45° FOV.
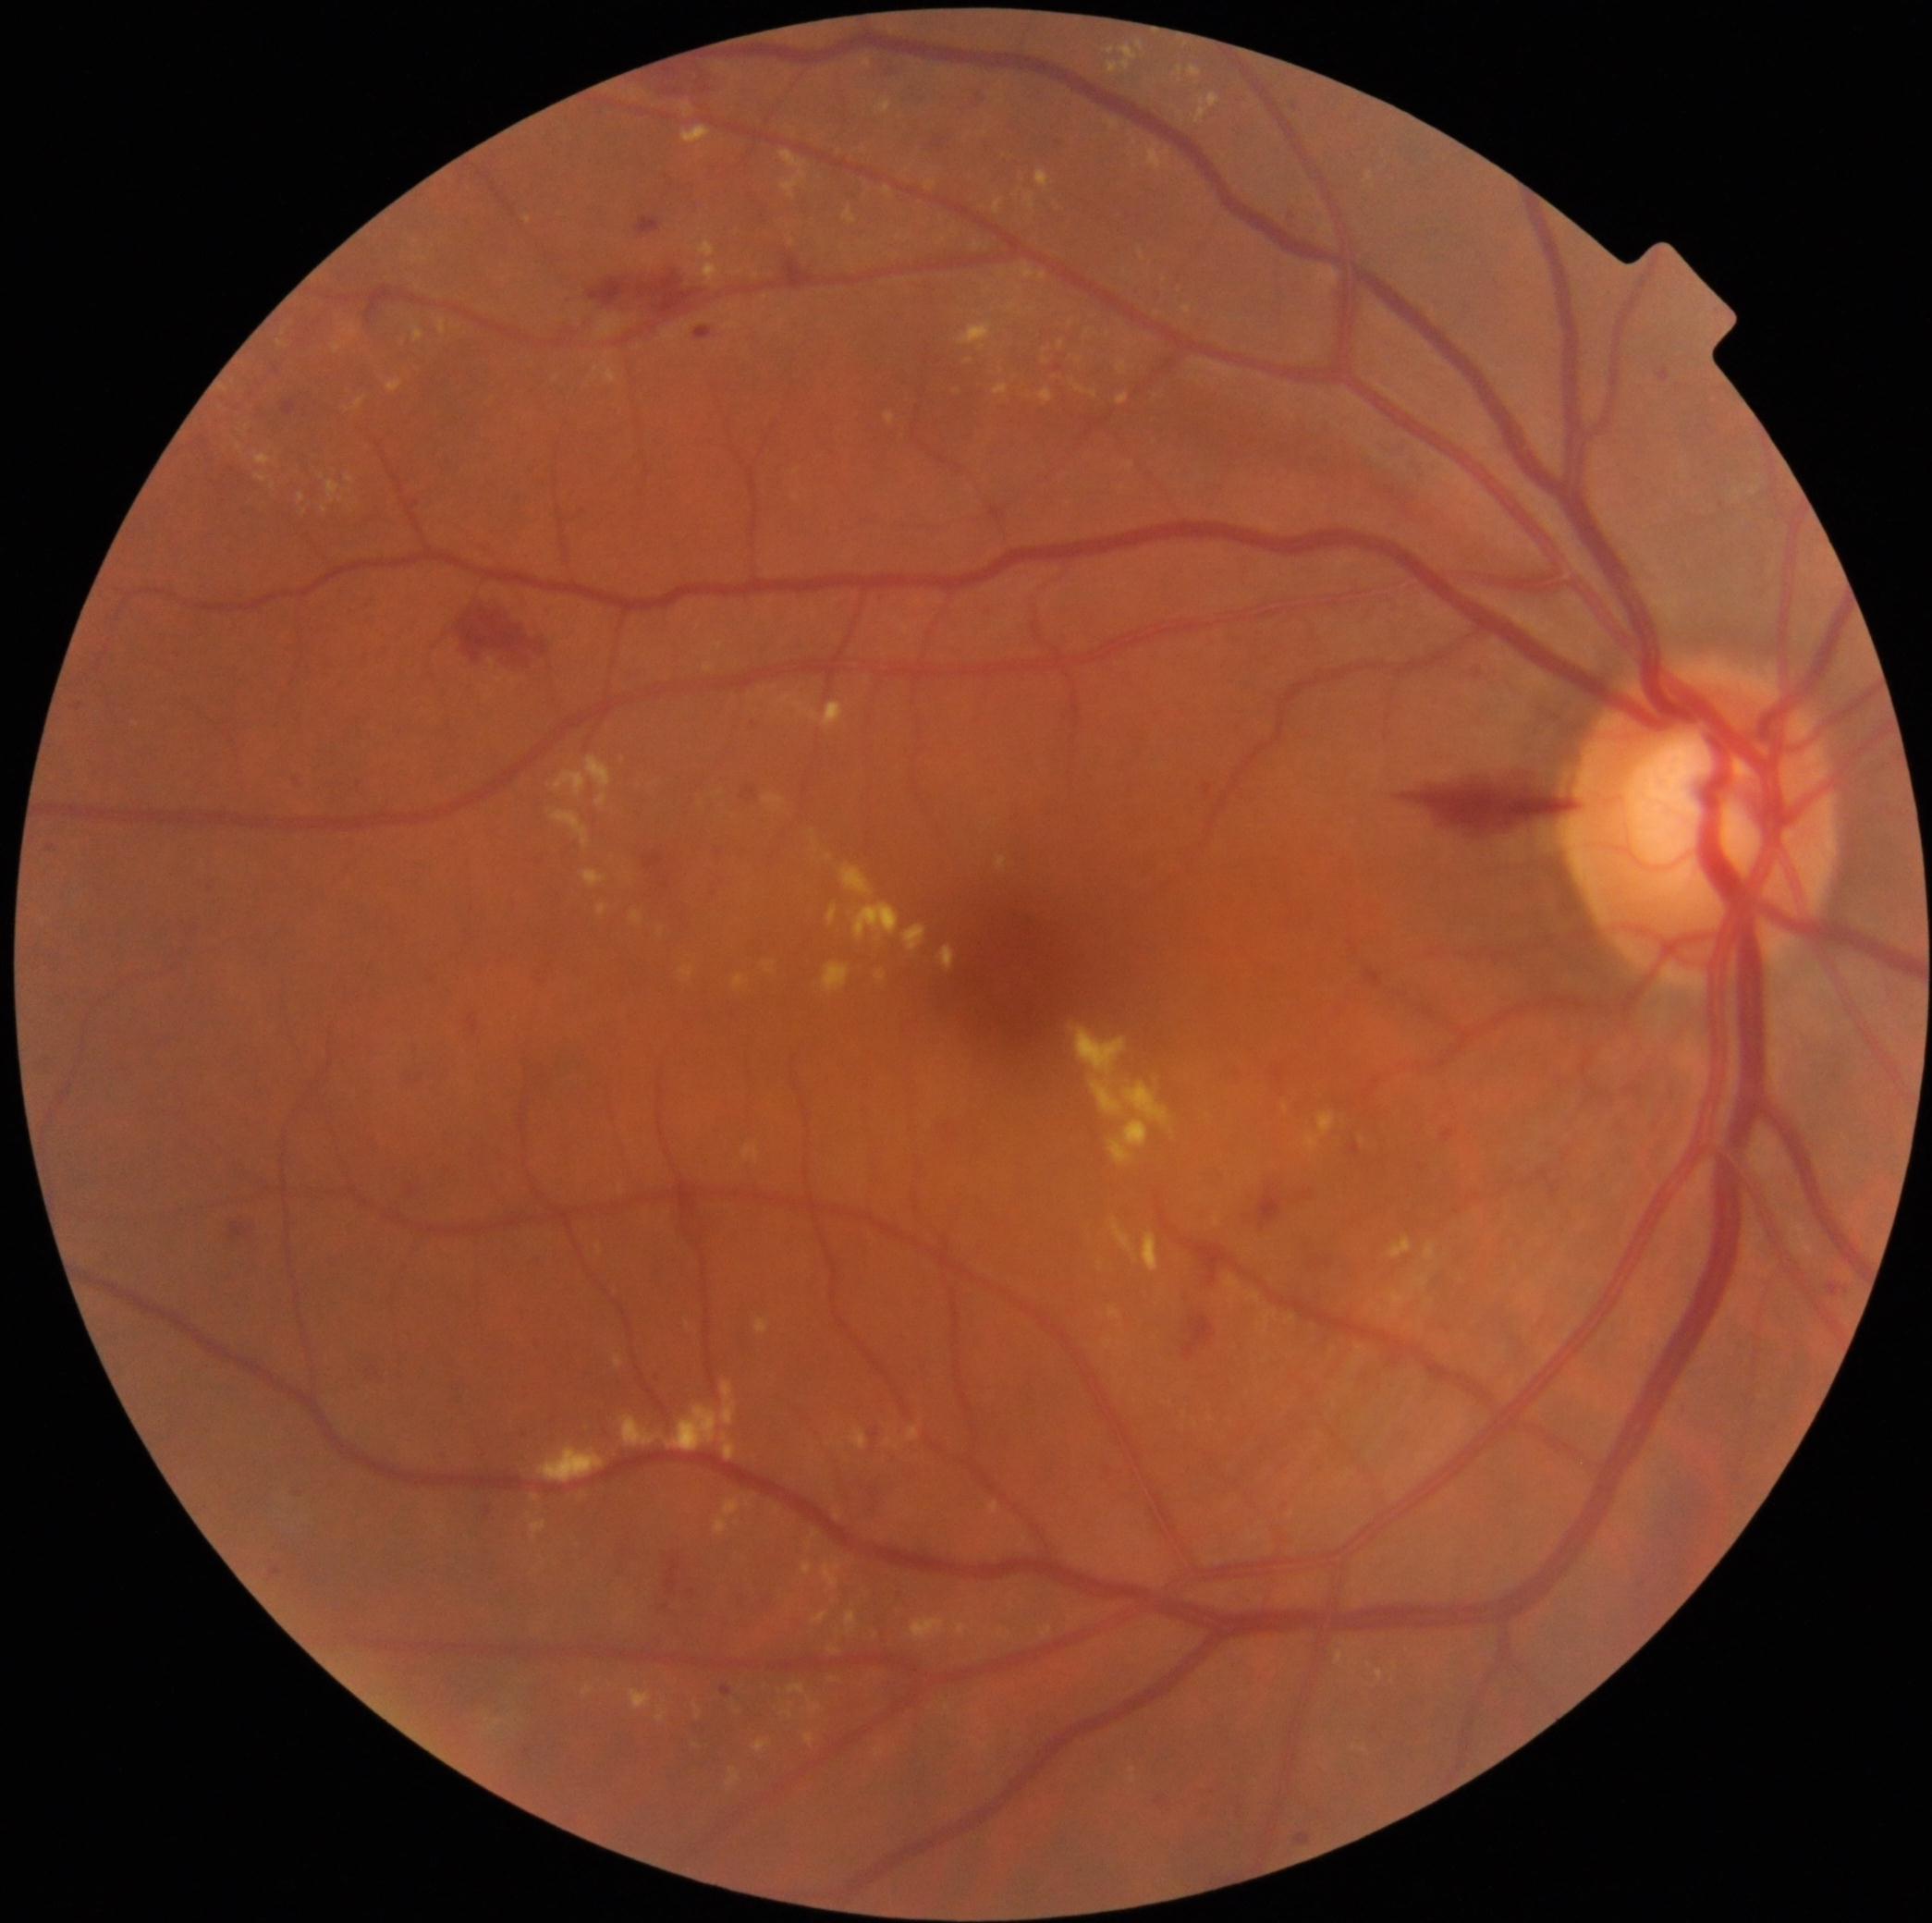

{"partial":true,"dr_grade":2,"lesions":{"ex":[[1100,1260,1104,1268],[1388,1236,1413,1258],[1226,1276,1241,1304],[780,695,791,704],[782,1702,795,1719],[1040,272,1048,282],[1040,1625,1054,1638],[278,341,287,348],[255,474,269,484],[556,772,587,798],[615,1353,625,1369],[531,1521,545,1537],[780,151,808,200]],"ex_small":[[1396,1667],[958,392],[969,362],[1004,275],[225,391],[721,793]]}}